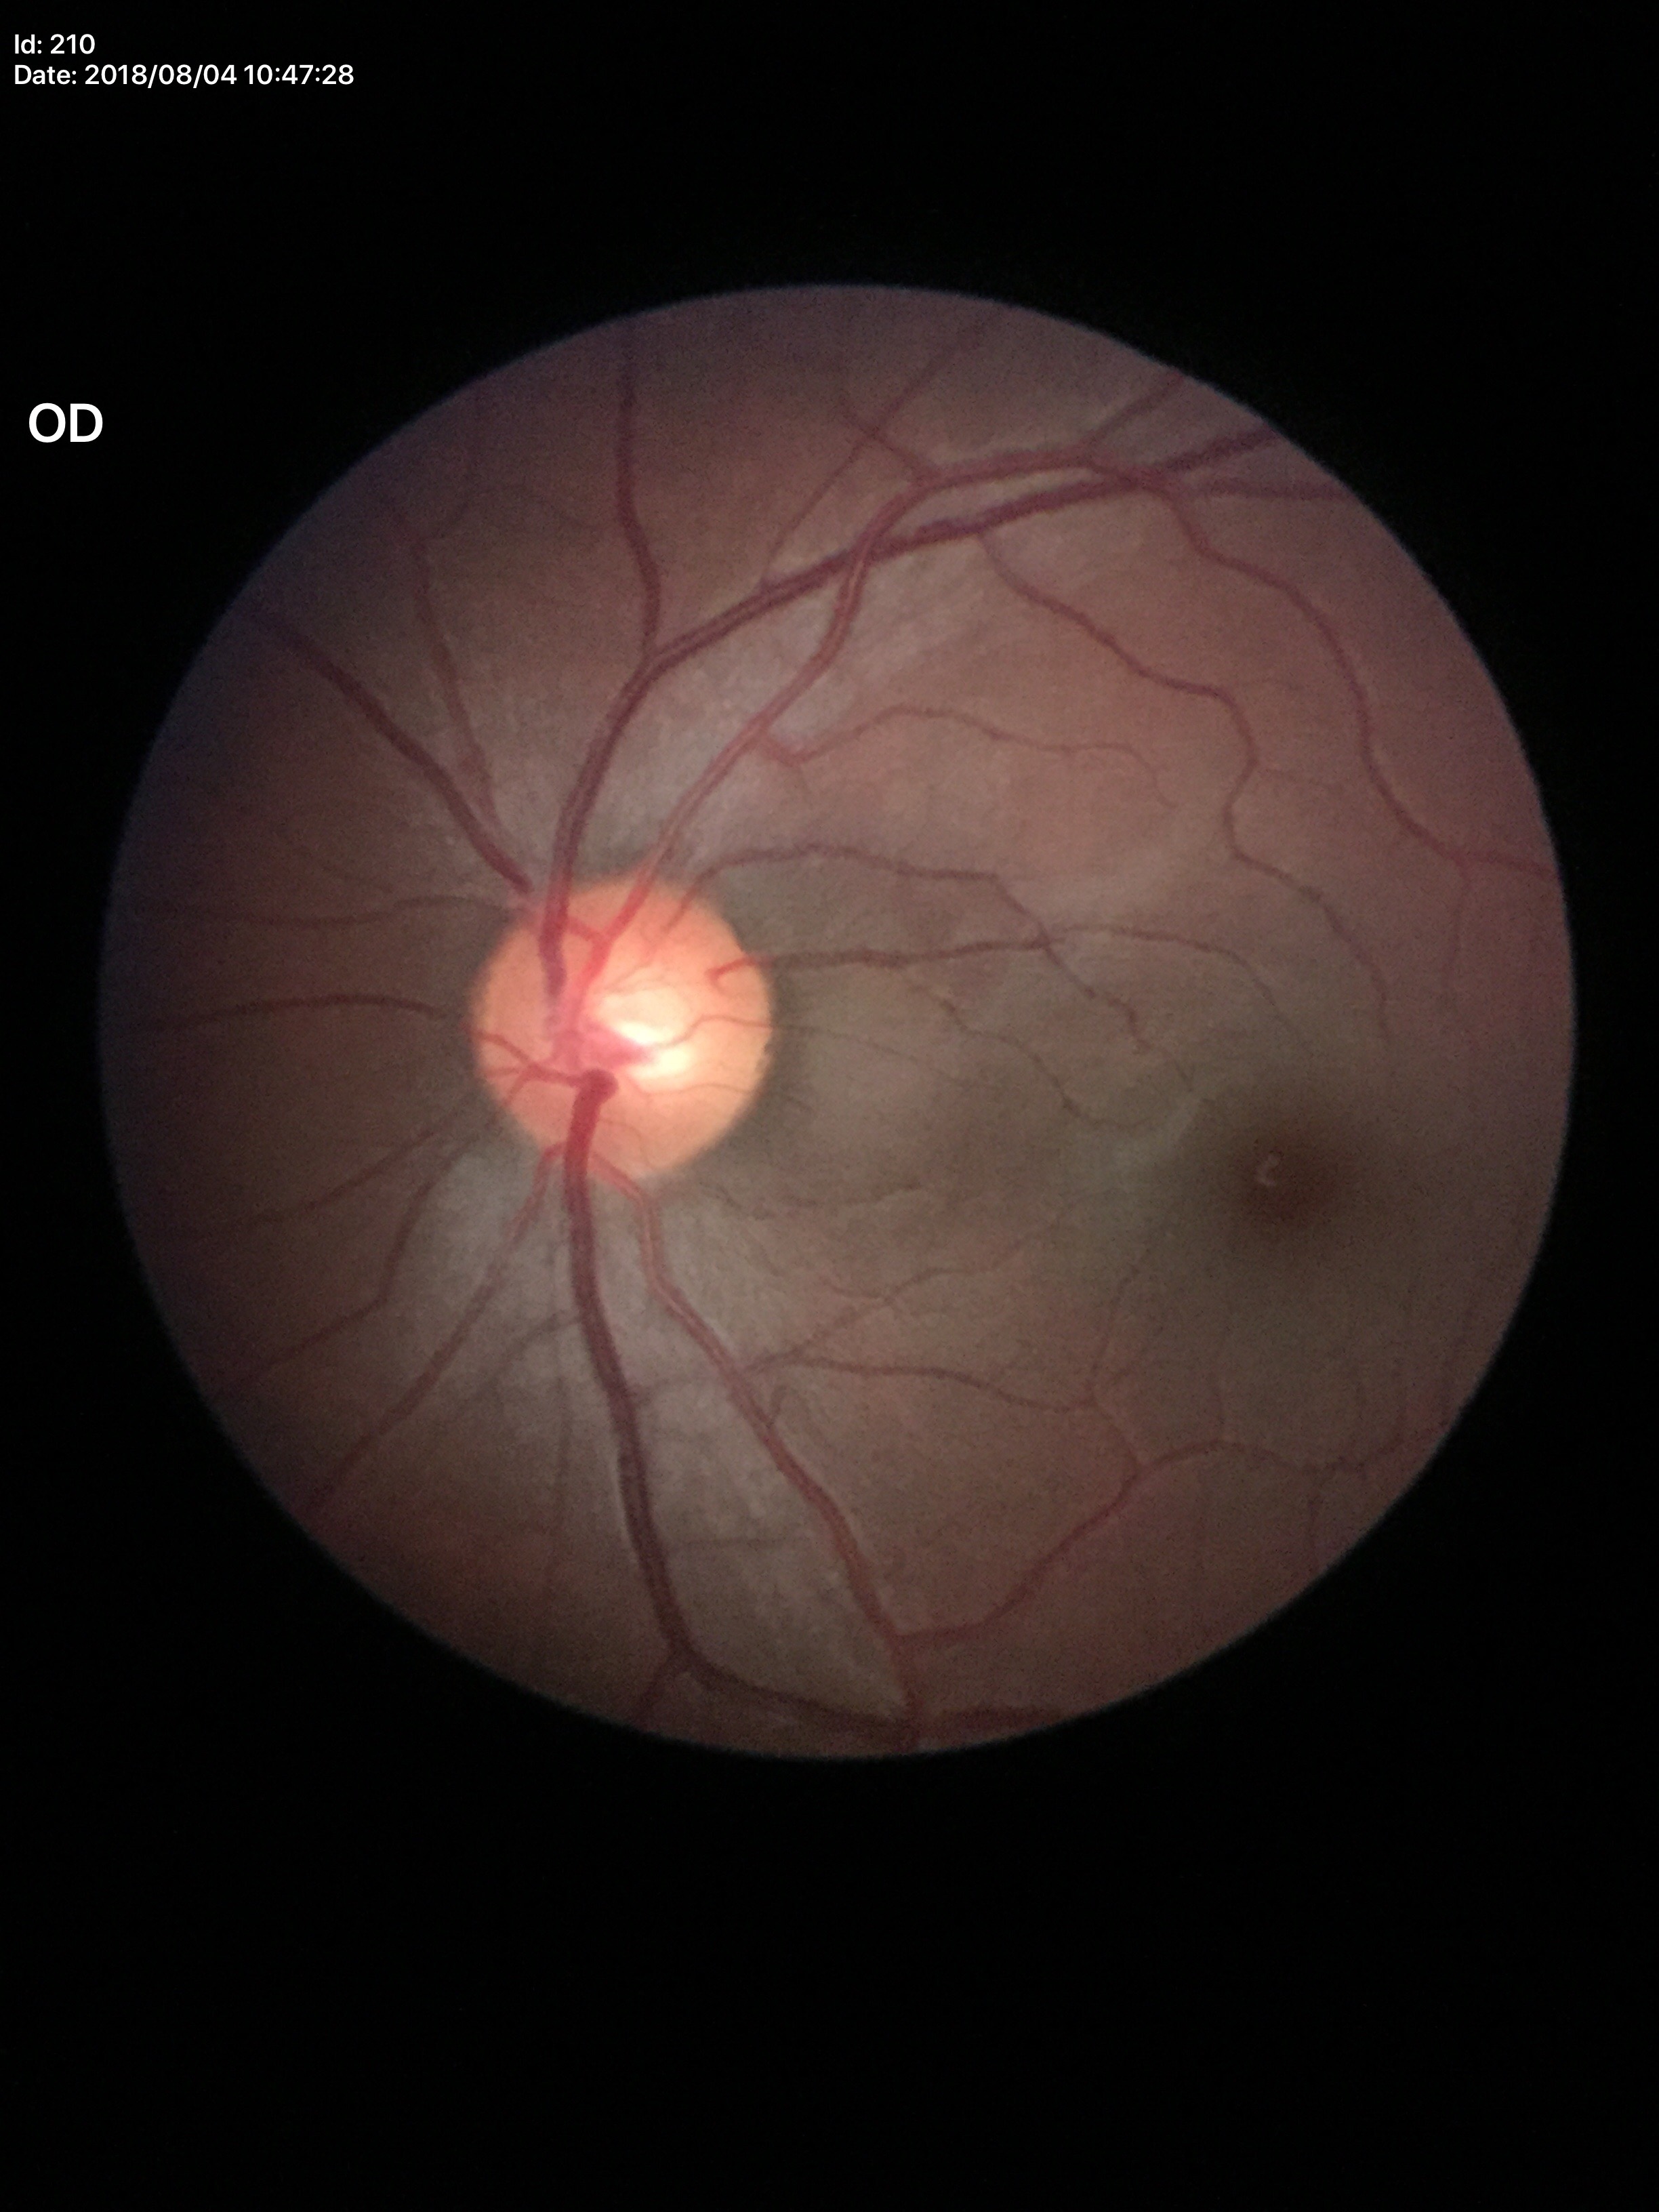

glaucoma_decision: no suspicious findings
vcdr: 0.53
hcdr: 0.56